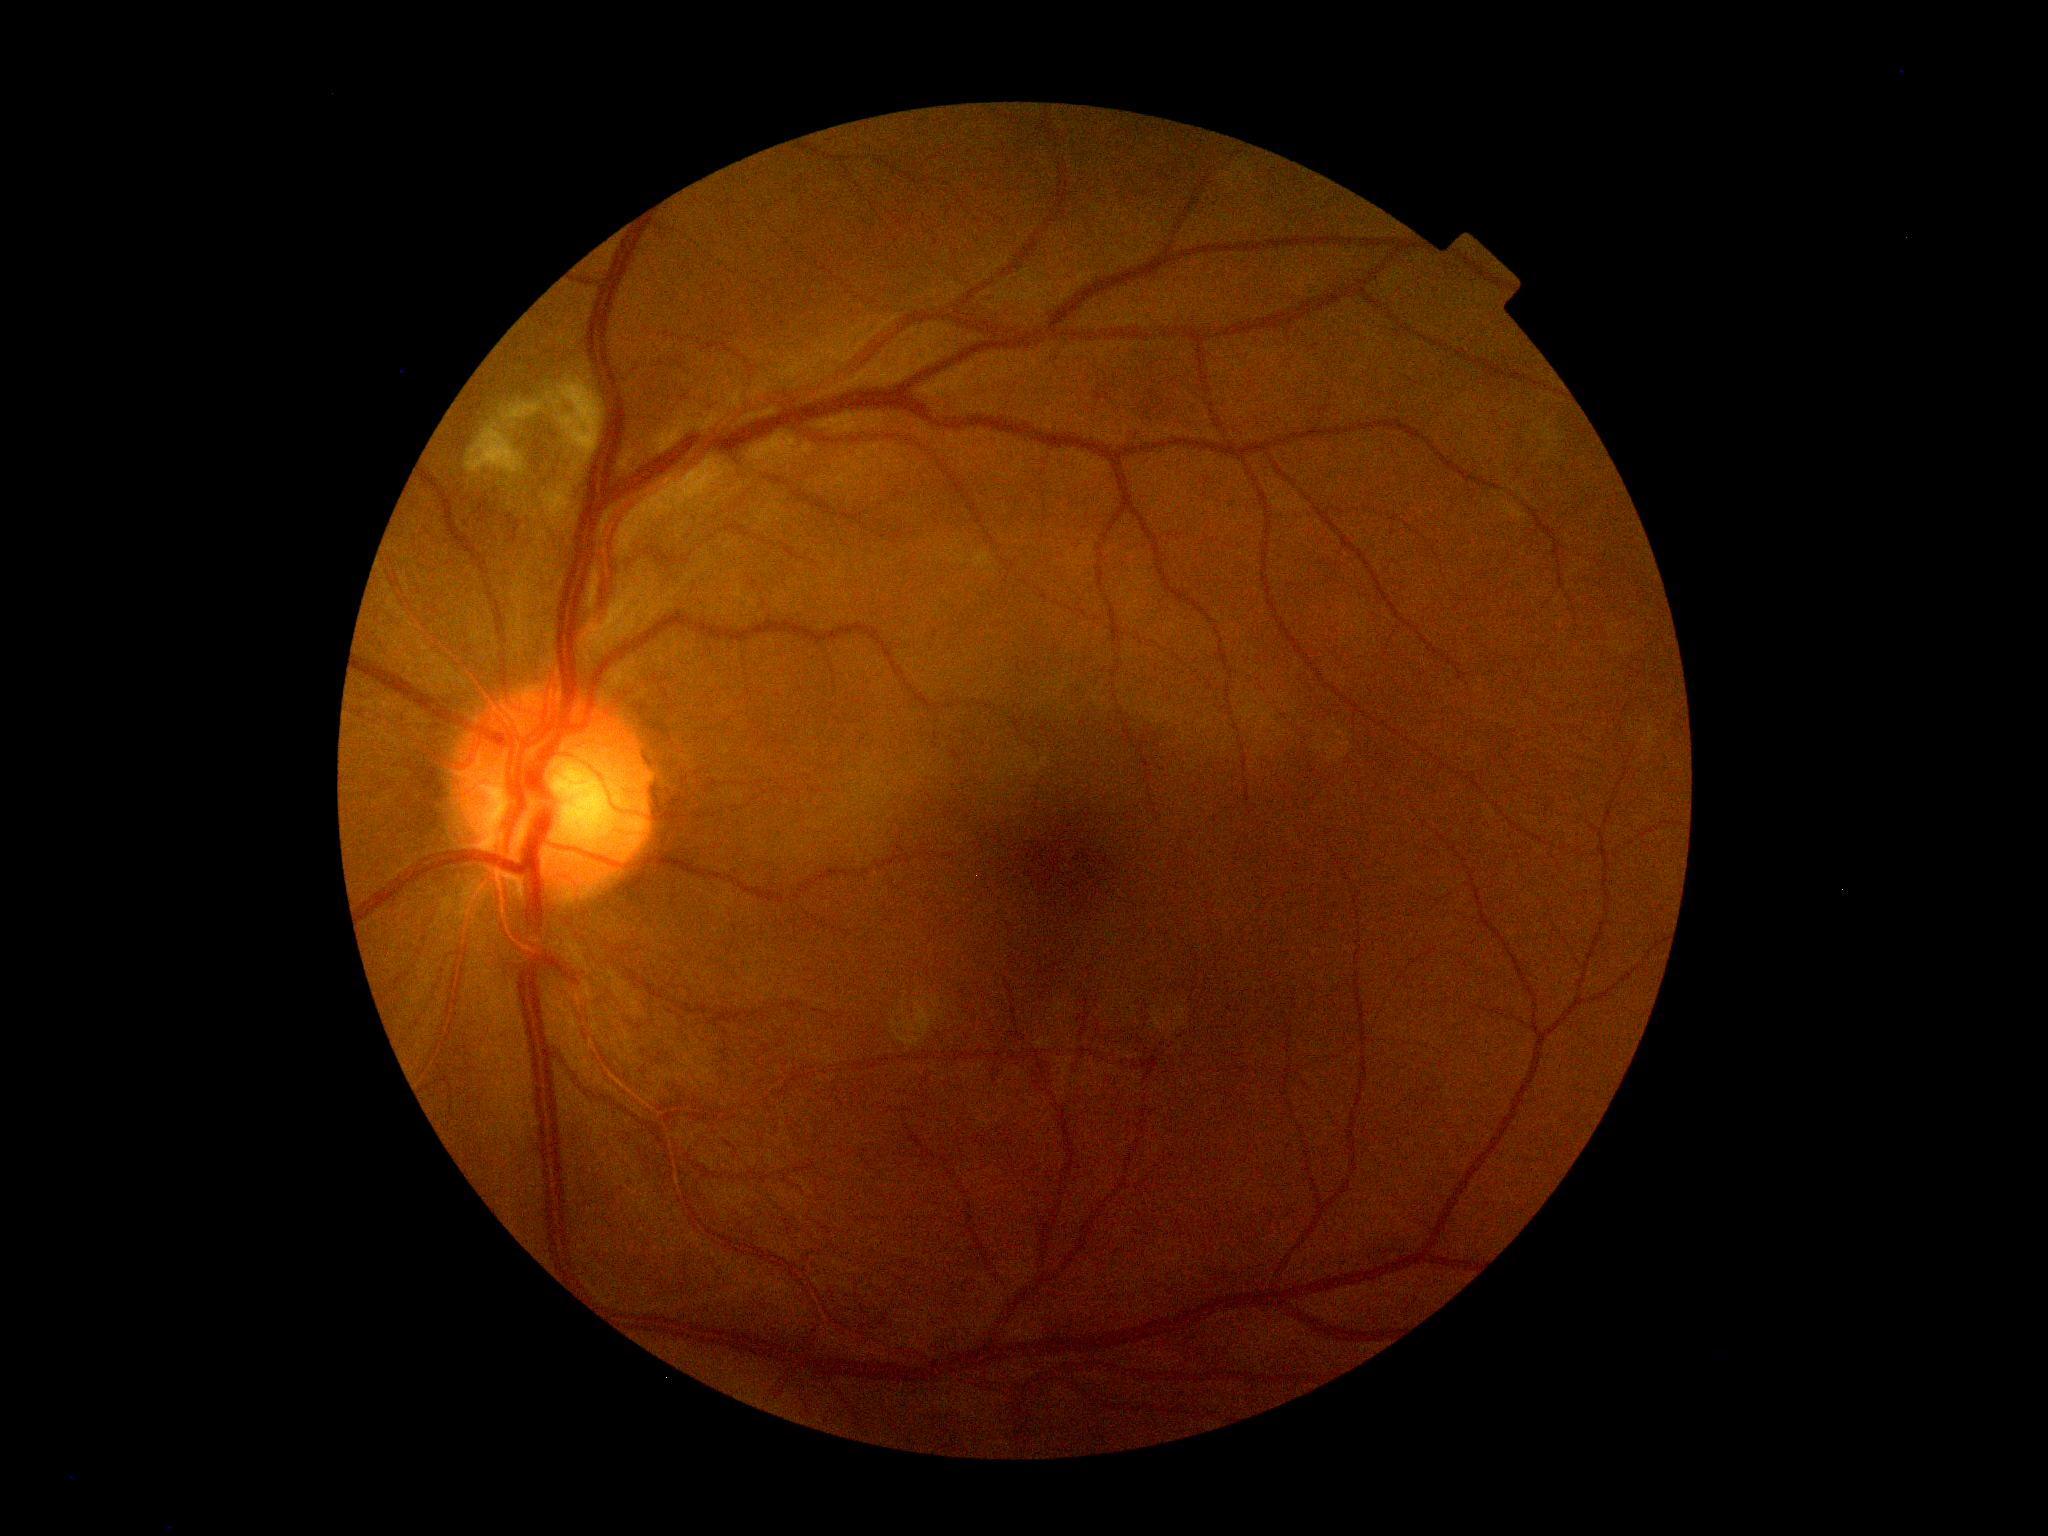 The retinopathy is classified as non-proliferative diabetic retinopathy.
Retinopathy grade is 2 (moderate NPDR).